45° field of view; 2352x1568px:
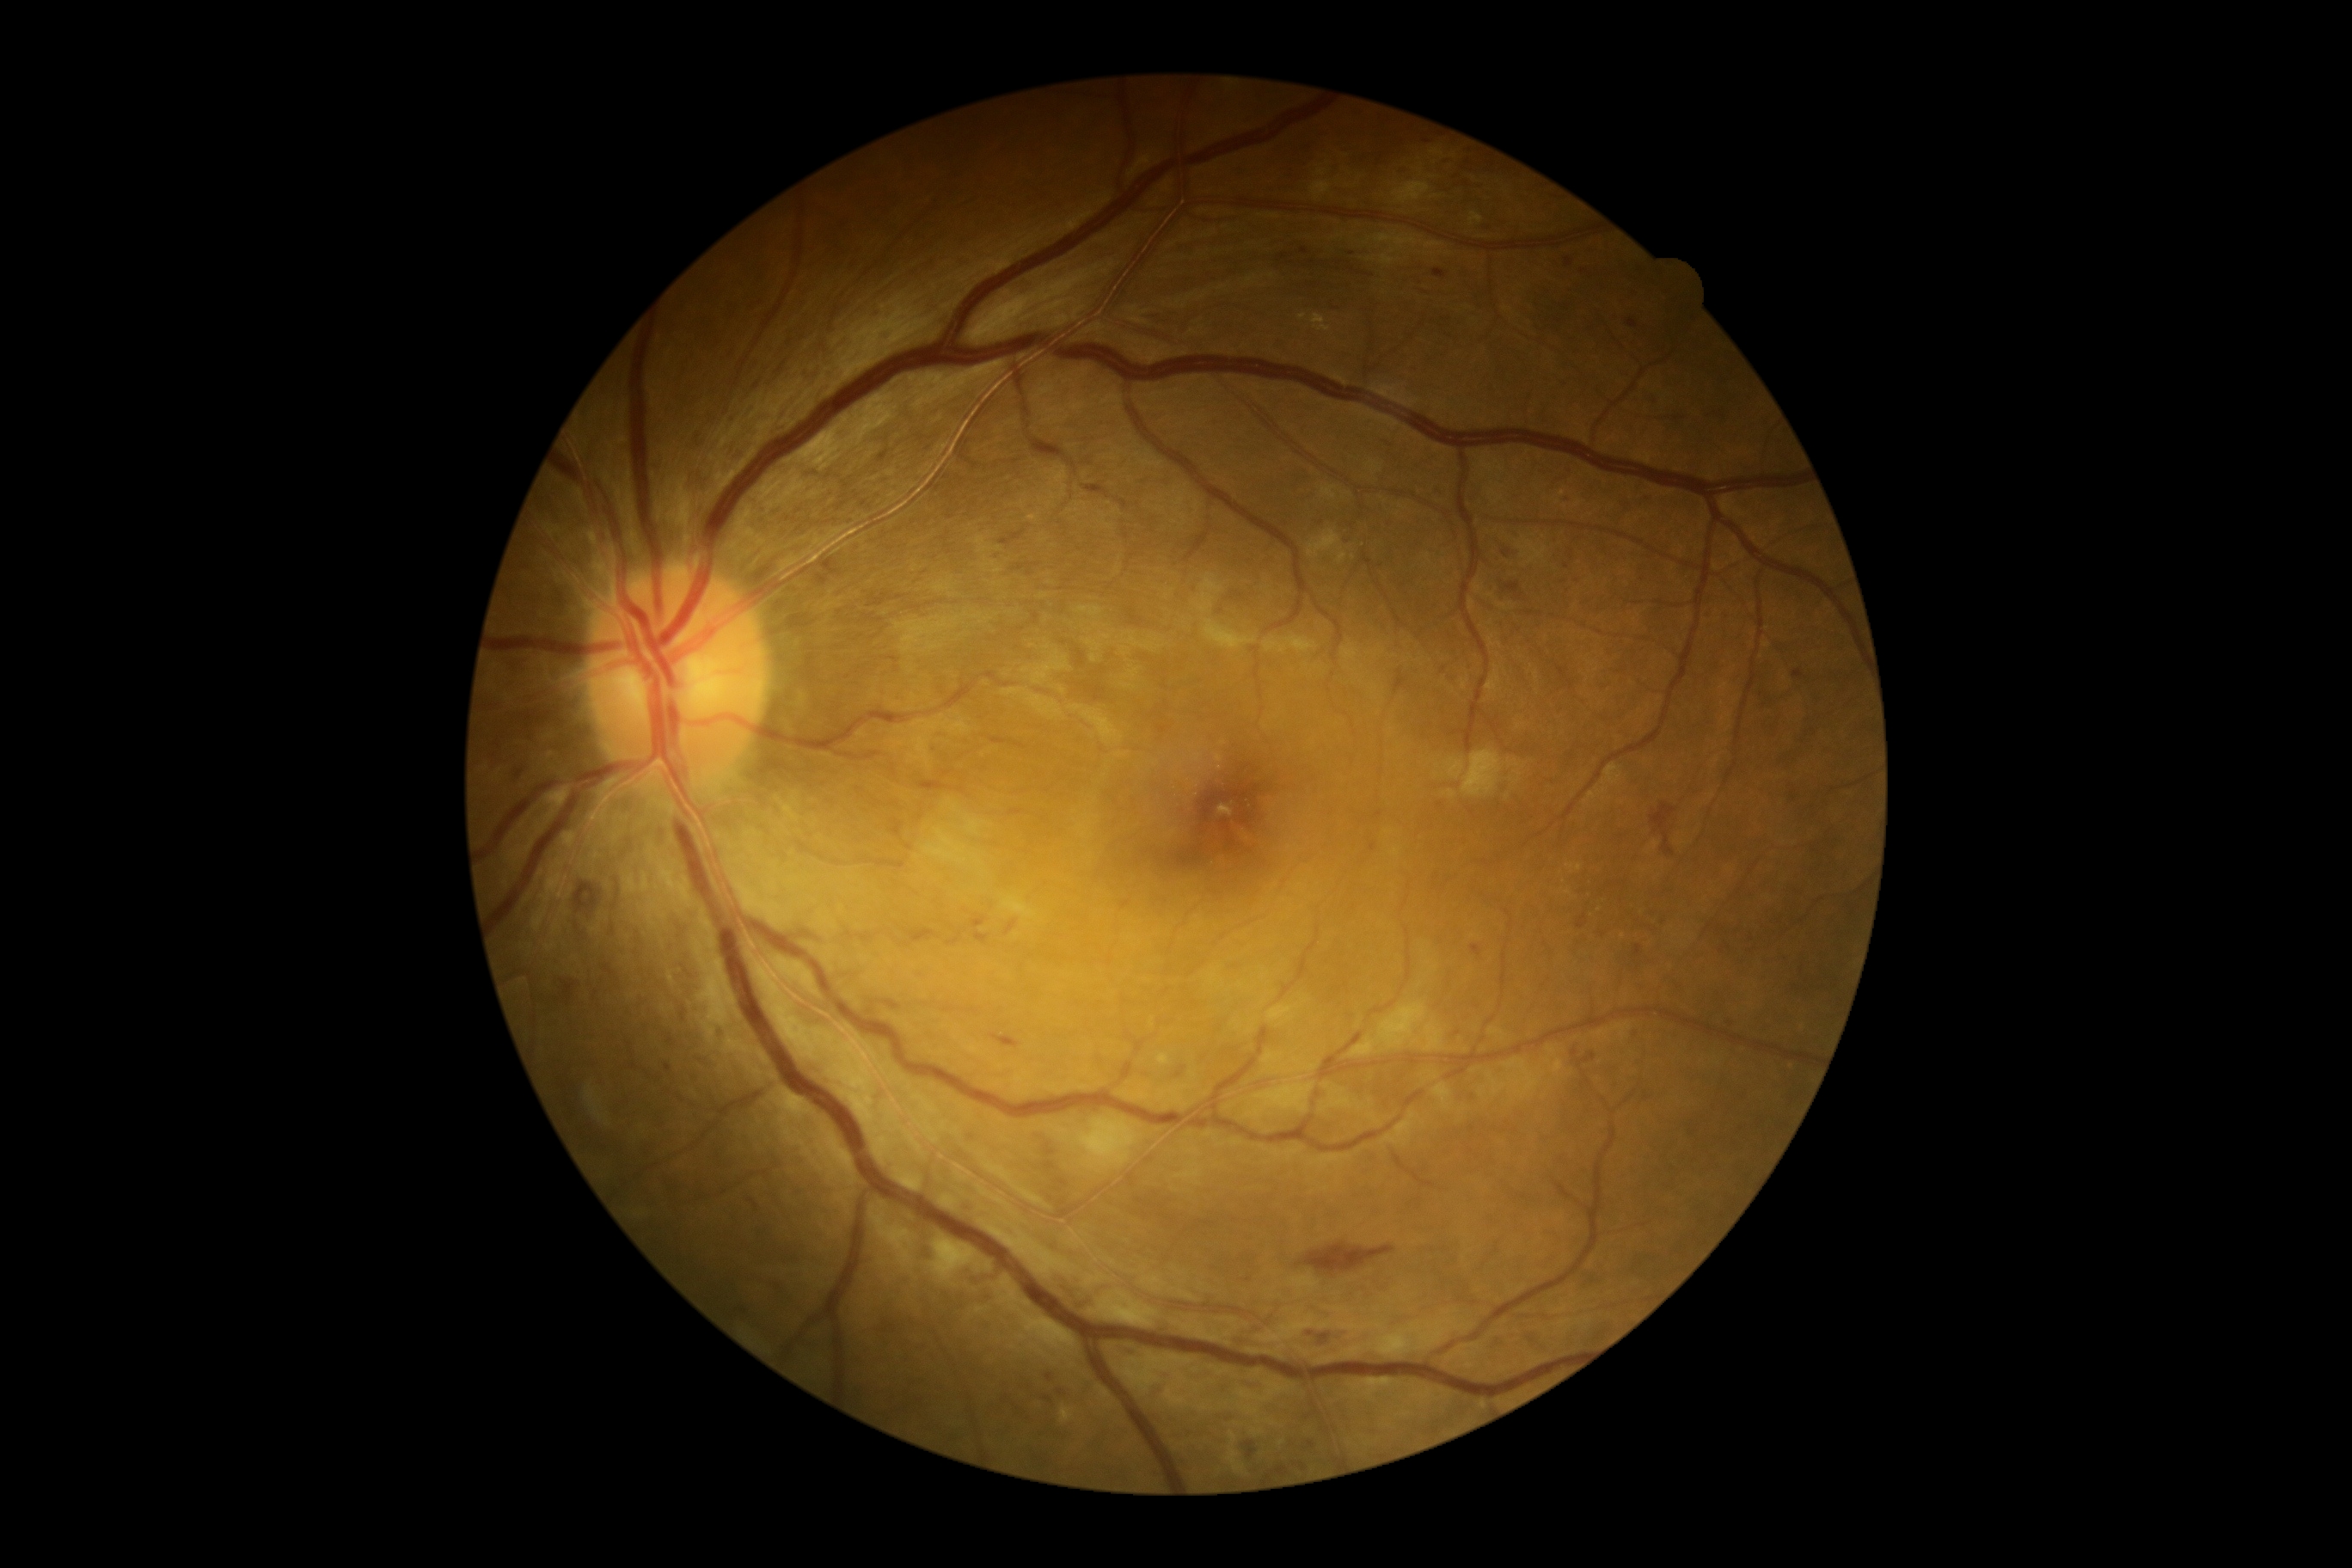
diabetic retinopathy (DR): moderate non-proliferative diabetic retinopathy (grade 2)